DR severity per modified Davis staging · 848 x 848 pixels · acquired with a NIDEK AFC-230:
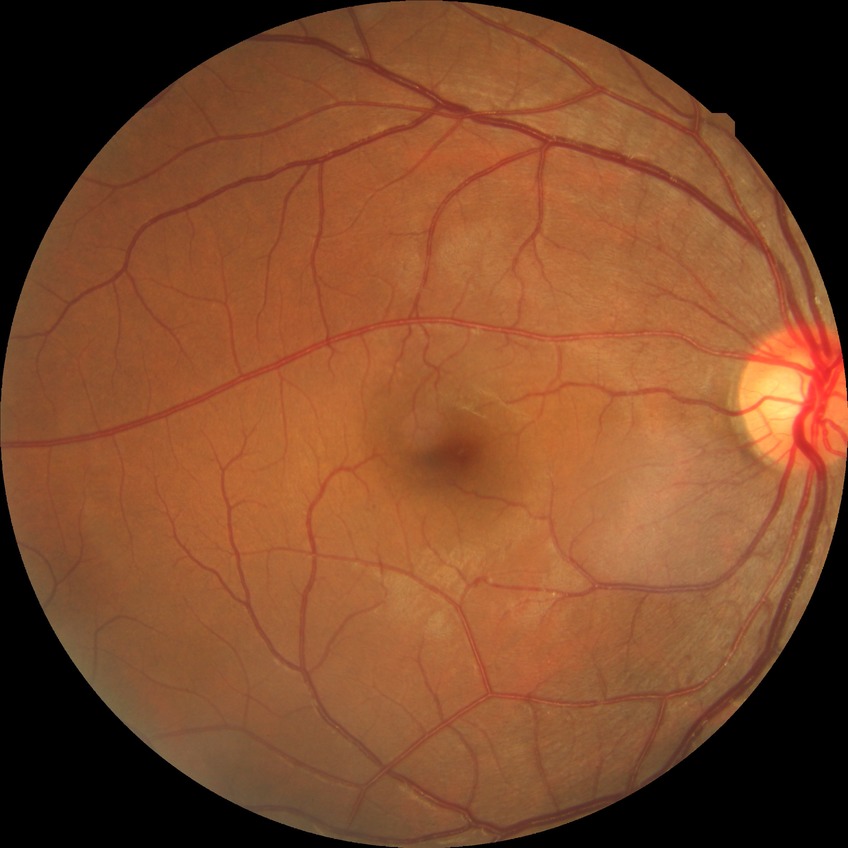

DR class: non-proliferative diabetic retinopathy. Modified Davis classification is simple diabetic retinopathy.